1240x1240; infant wide-field fundus photograph; captured with the Phoenix ICON (100° field of view): 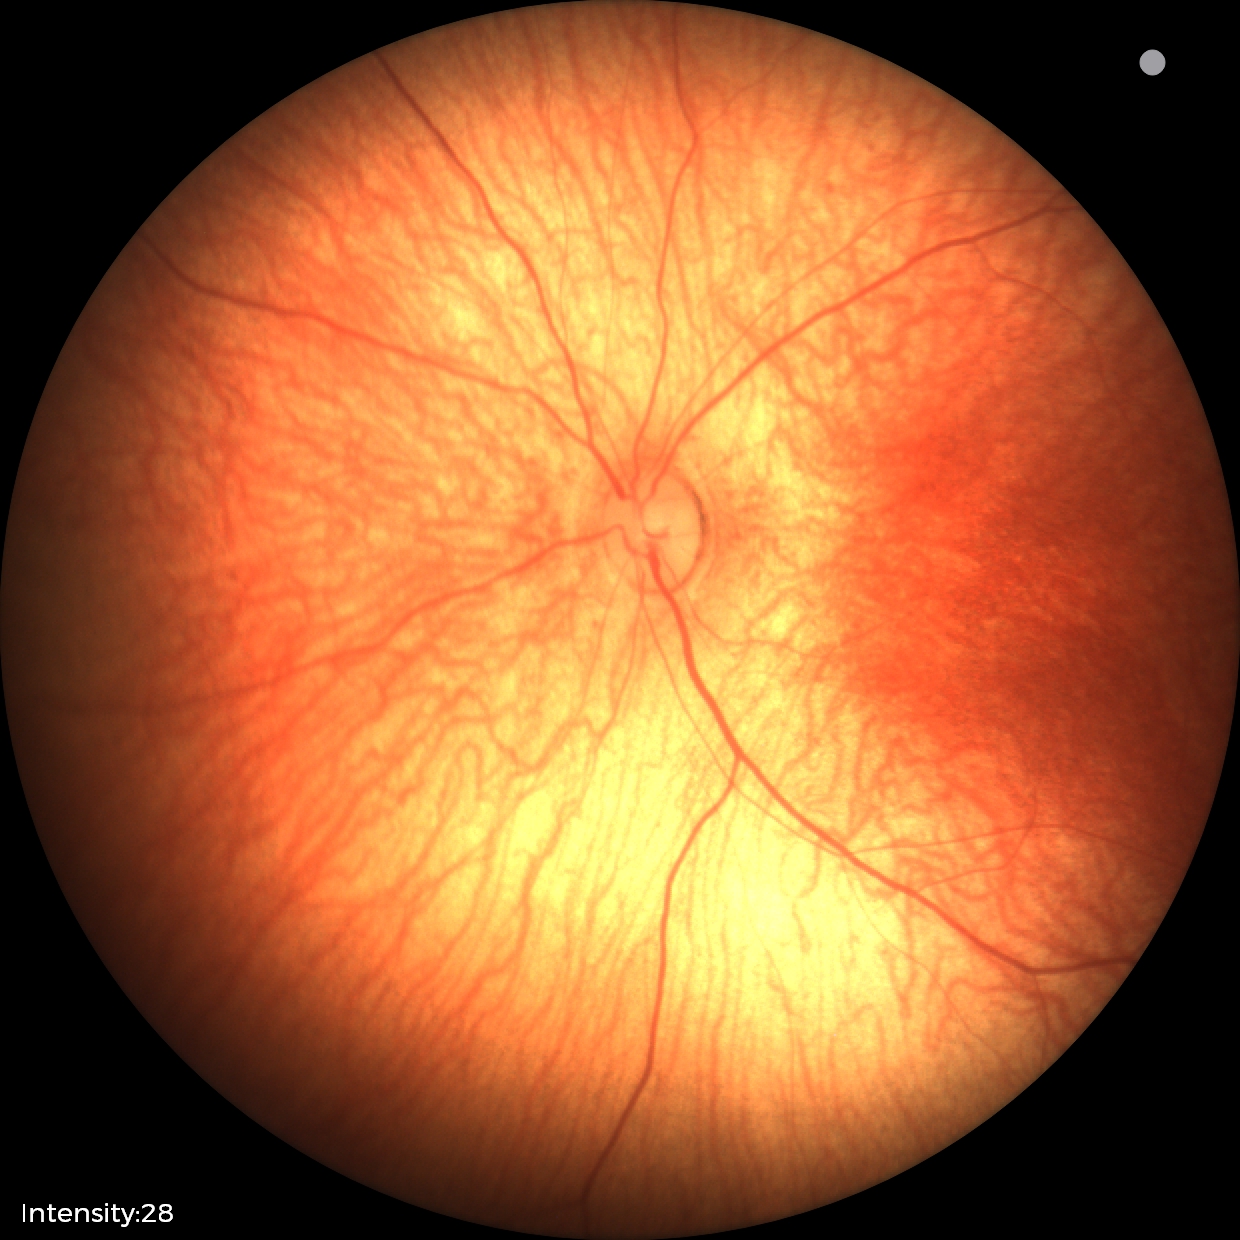 Assessment: normal fundus examination.